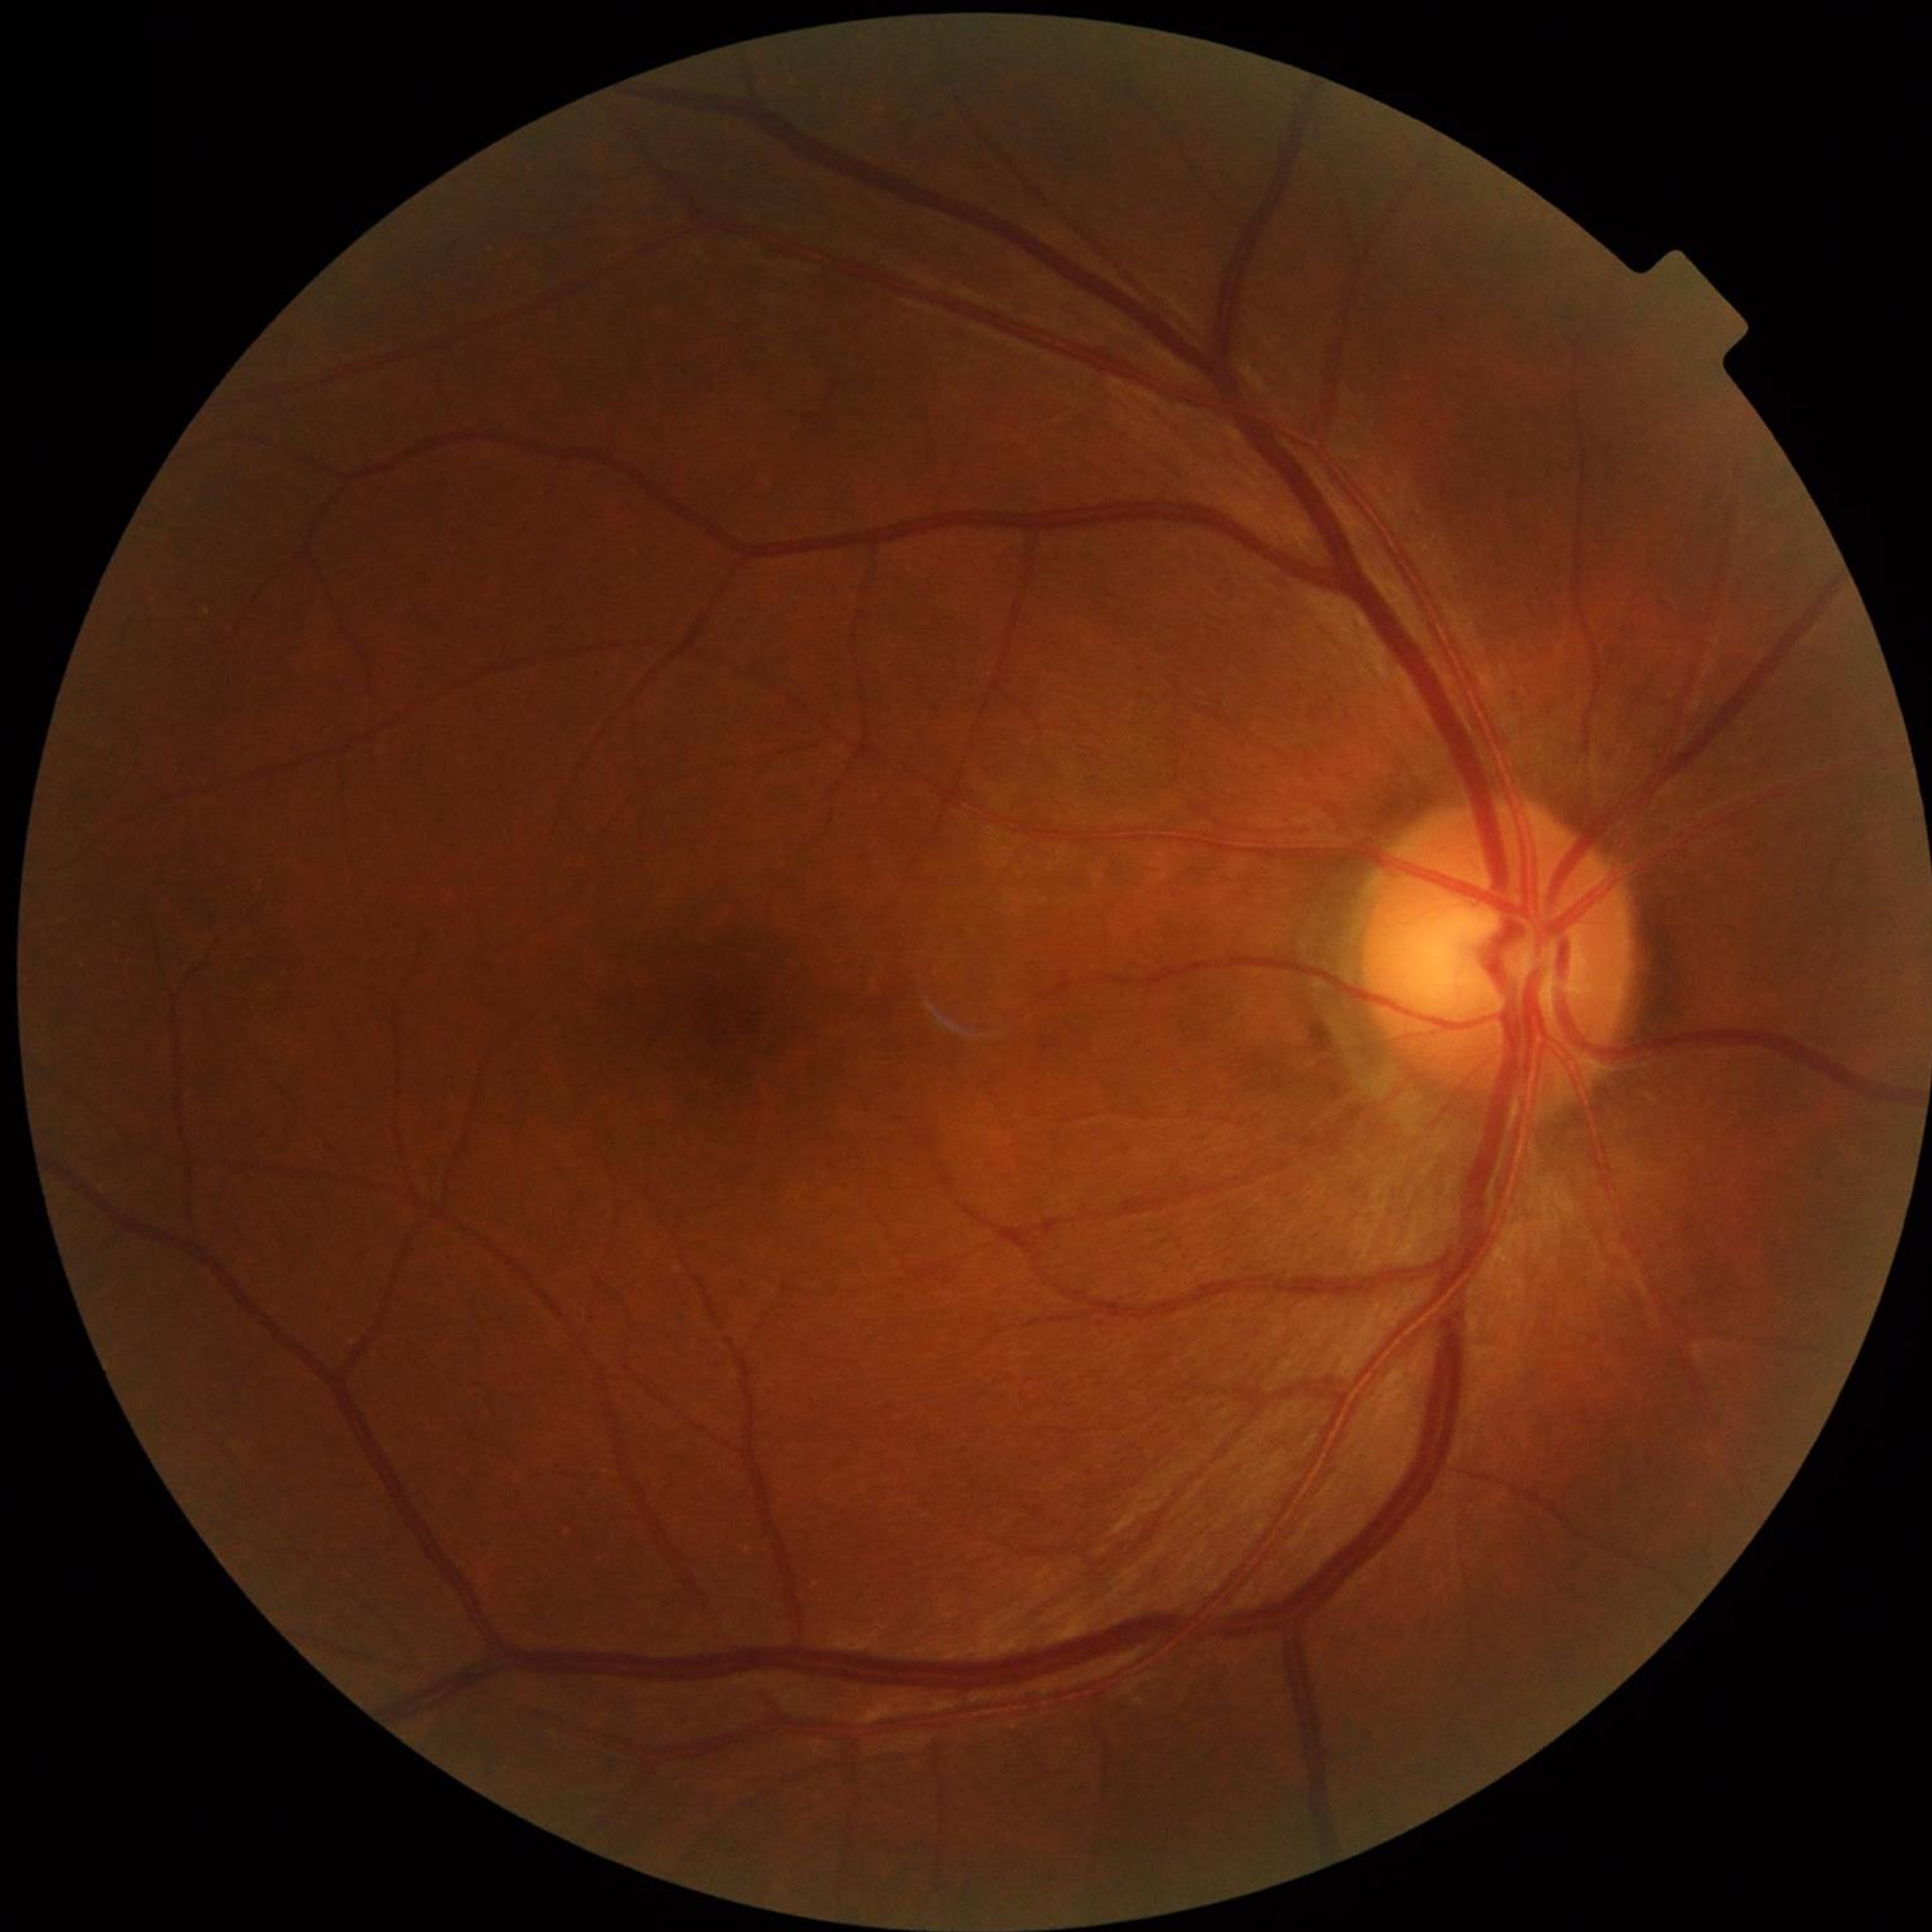

Retinal fundus photograph from a control without AMD, DR, or glaucoma.
Photo quality: adequate.